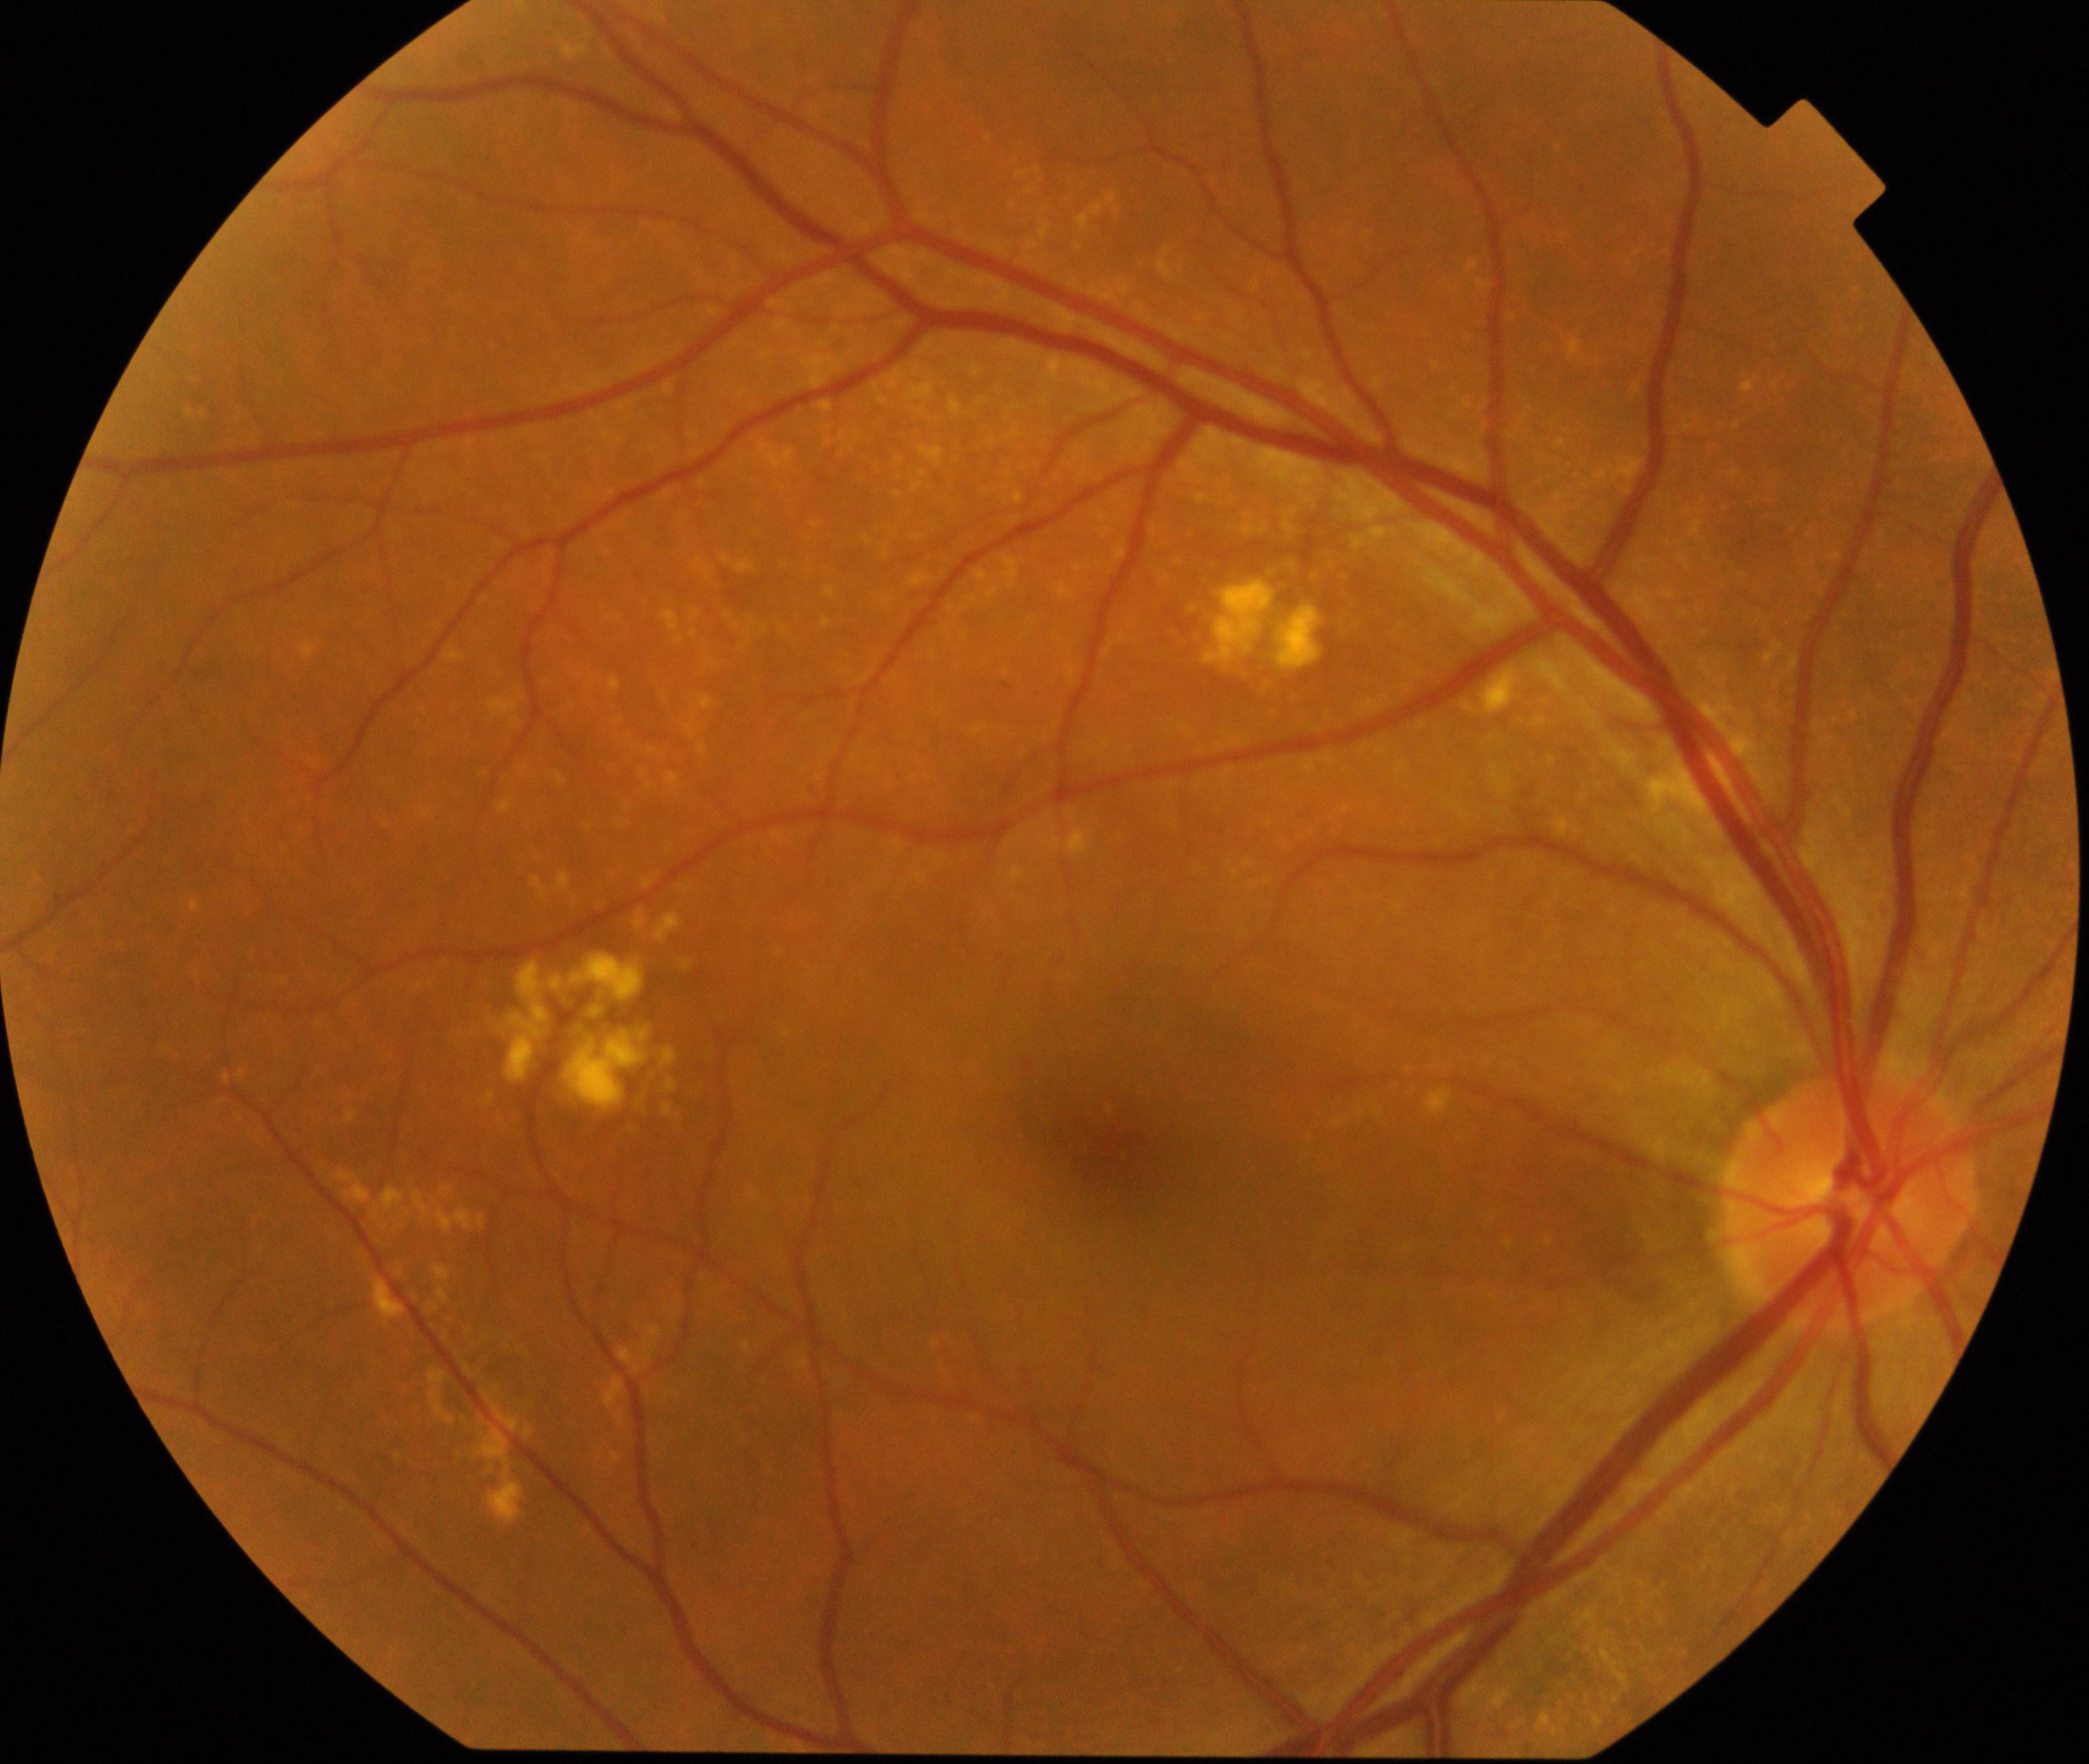 The image shows yellow-white spots or flecks.